Ultra-widefield (UWF) fundus image:
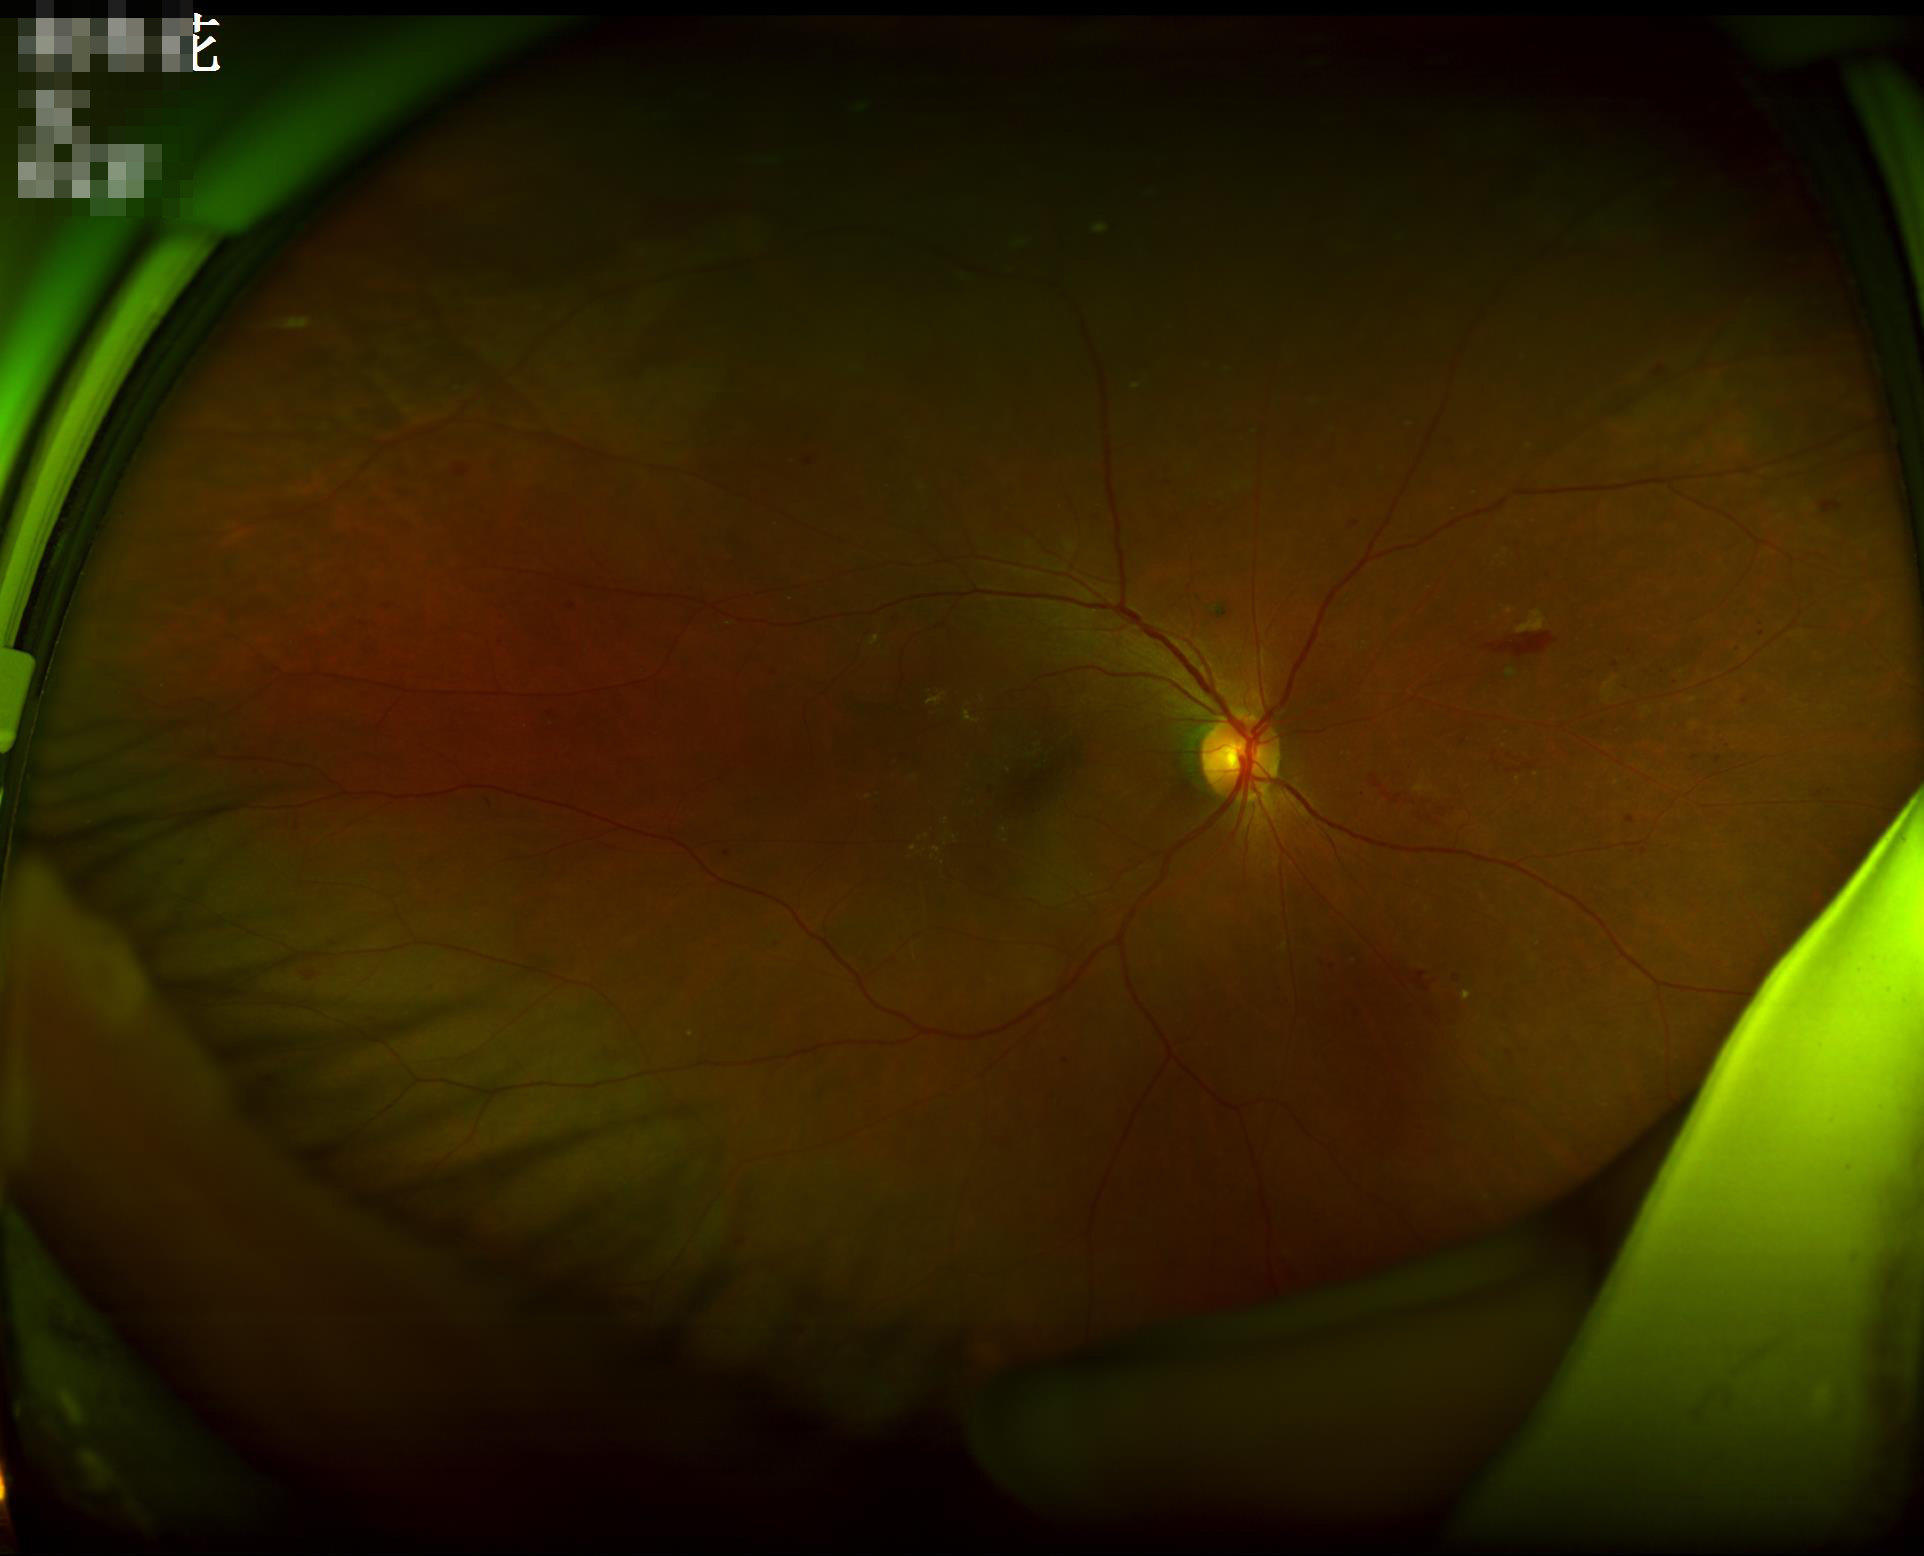

There is over- or under-exposure or a color cast. Adequate contrast for distinguishing structures.